No pharmacologic dilation, 848 by 848 pixels, 45 degree fundus photograph.
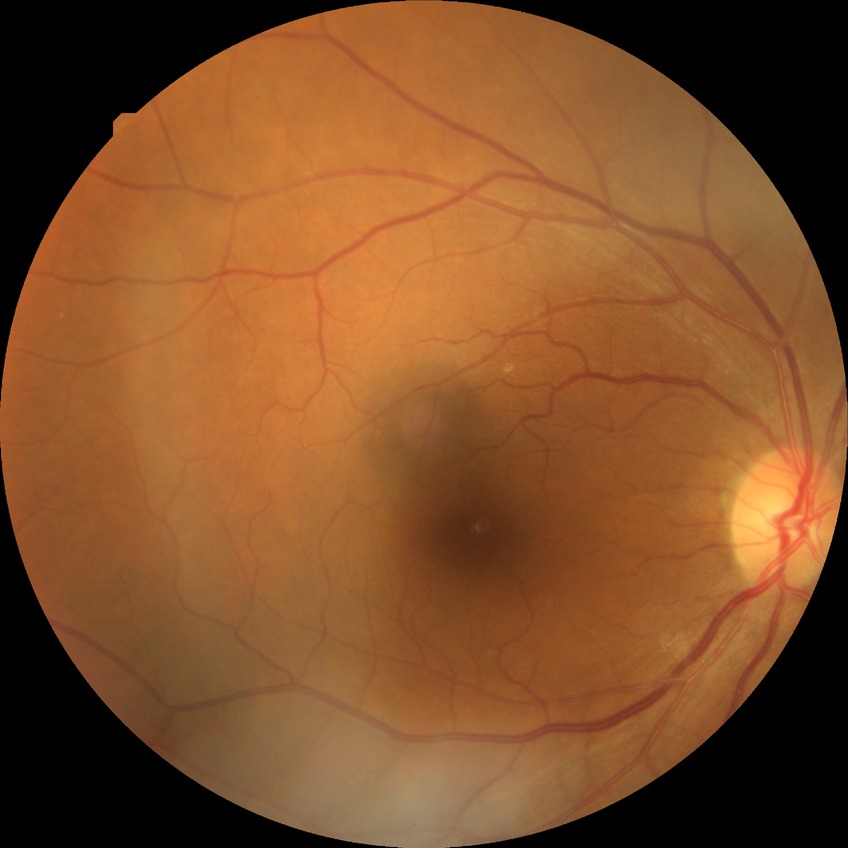

diabetic retinopathy (DR) = NDR (no diabetic retinopathy).